CFP
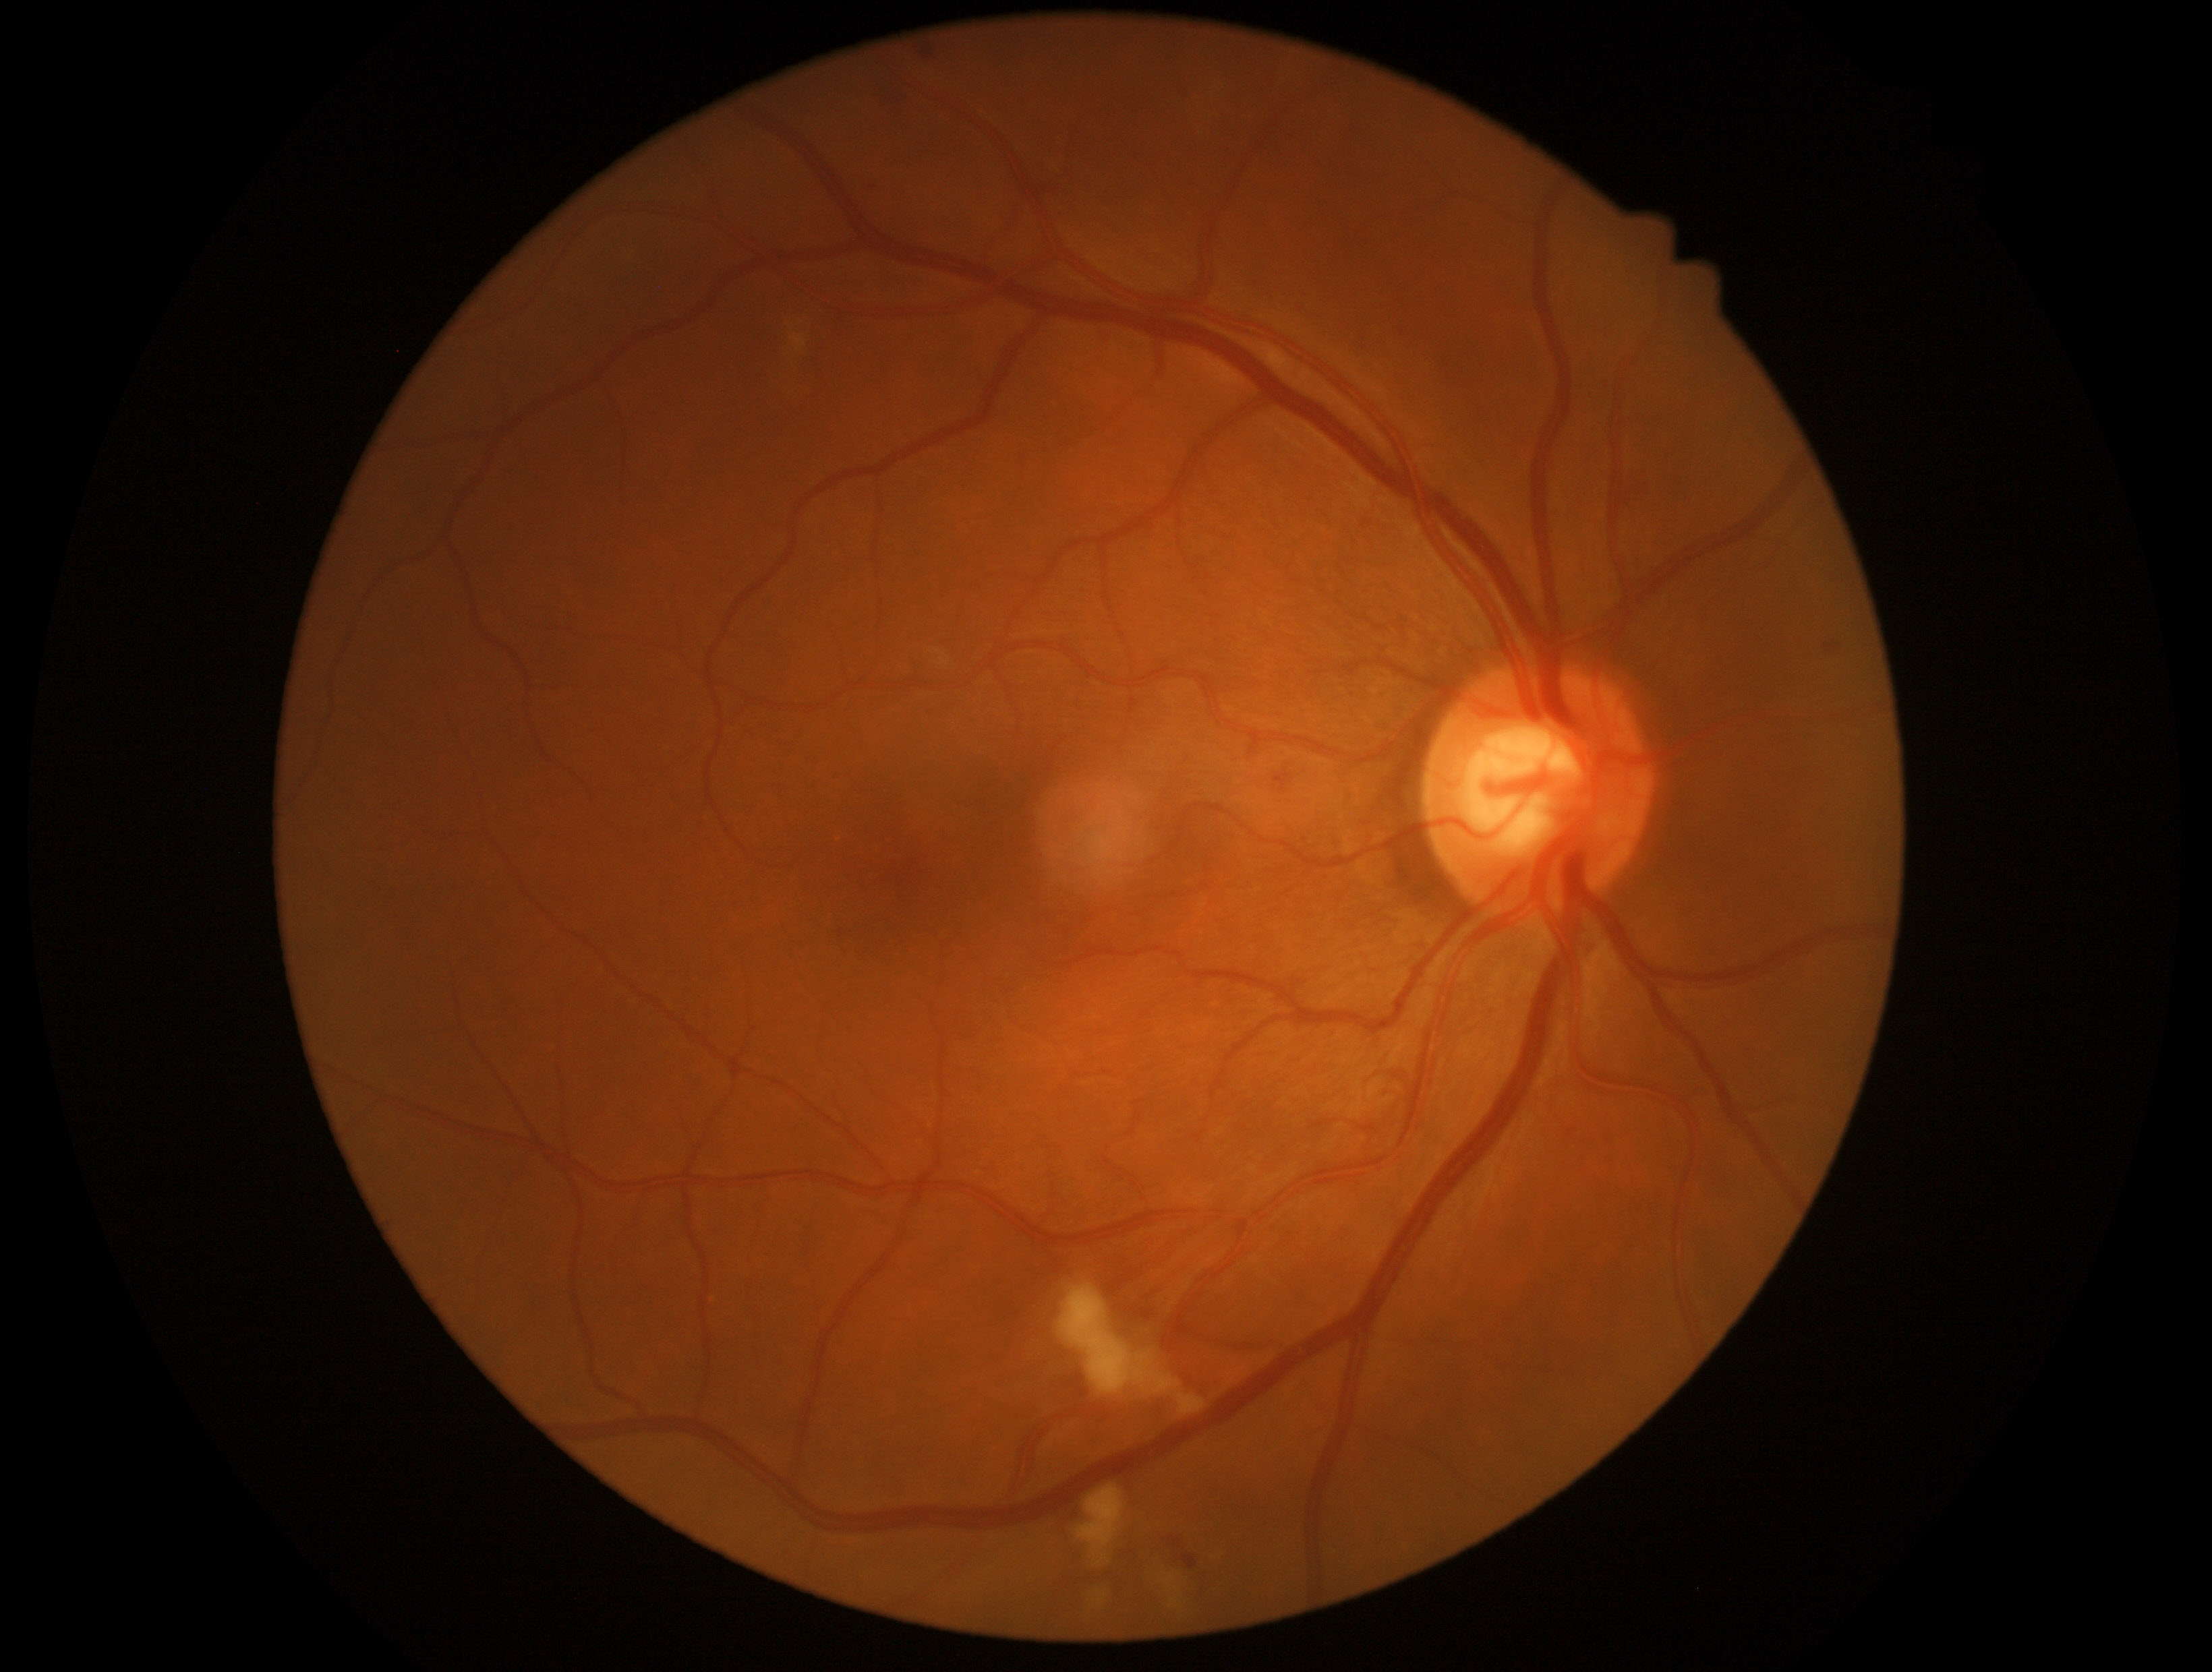

dr_grade: moderate non-proliferative diabetic retinopathy (grade 2) — more than just microaneurysms but less than severe NPDR